Image size 848x848.
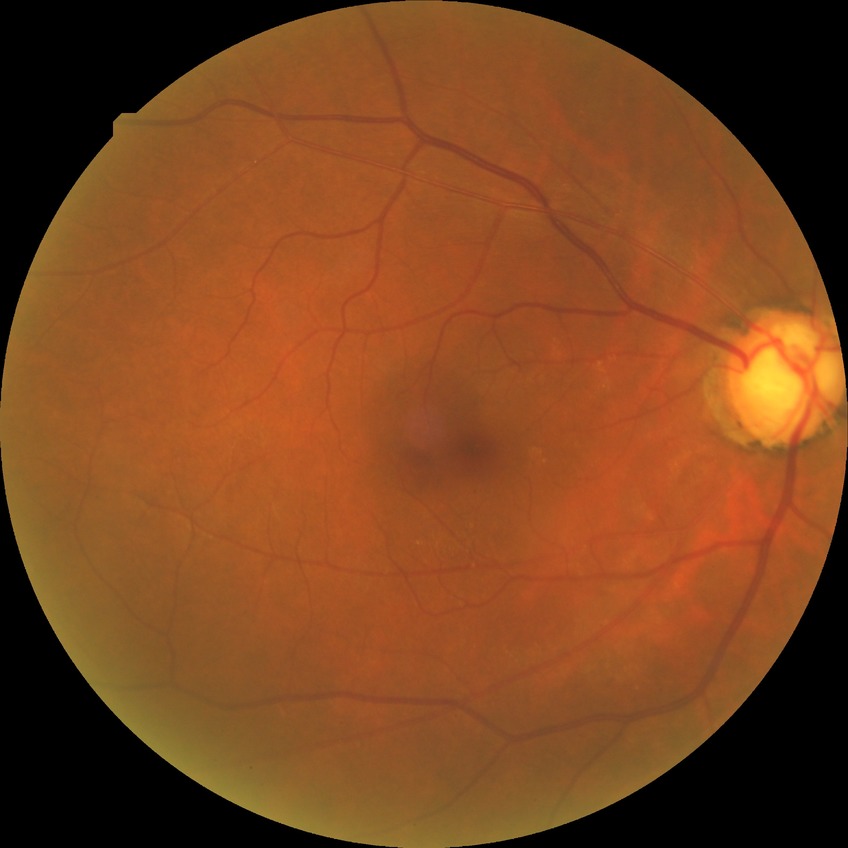
davis_grade: NDR (no diabetic retinopathy)